Infant wide-field fundus photograph. Acquired on the Phoenix ICON:
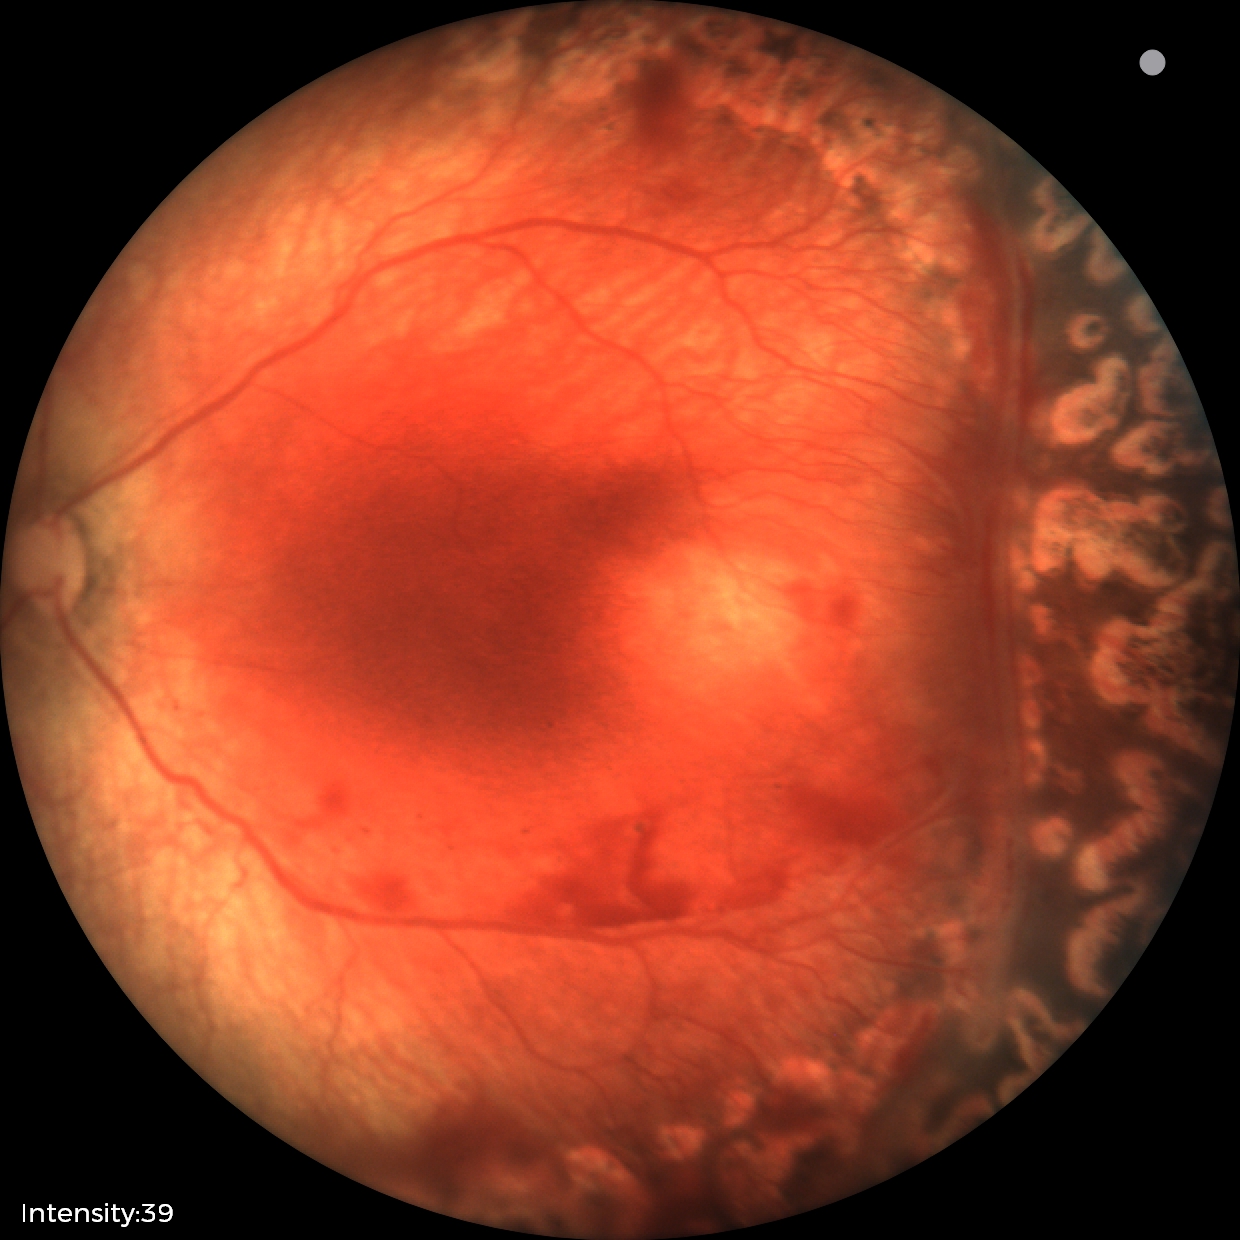
From an examination with diagnosis of status post retinopathy of prematurity.